Wide-field fundus image from infant ROP screening · acquired on the Phoenix ICON · 1240 x 1240 pixels — 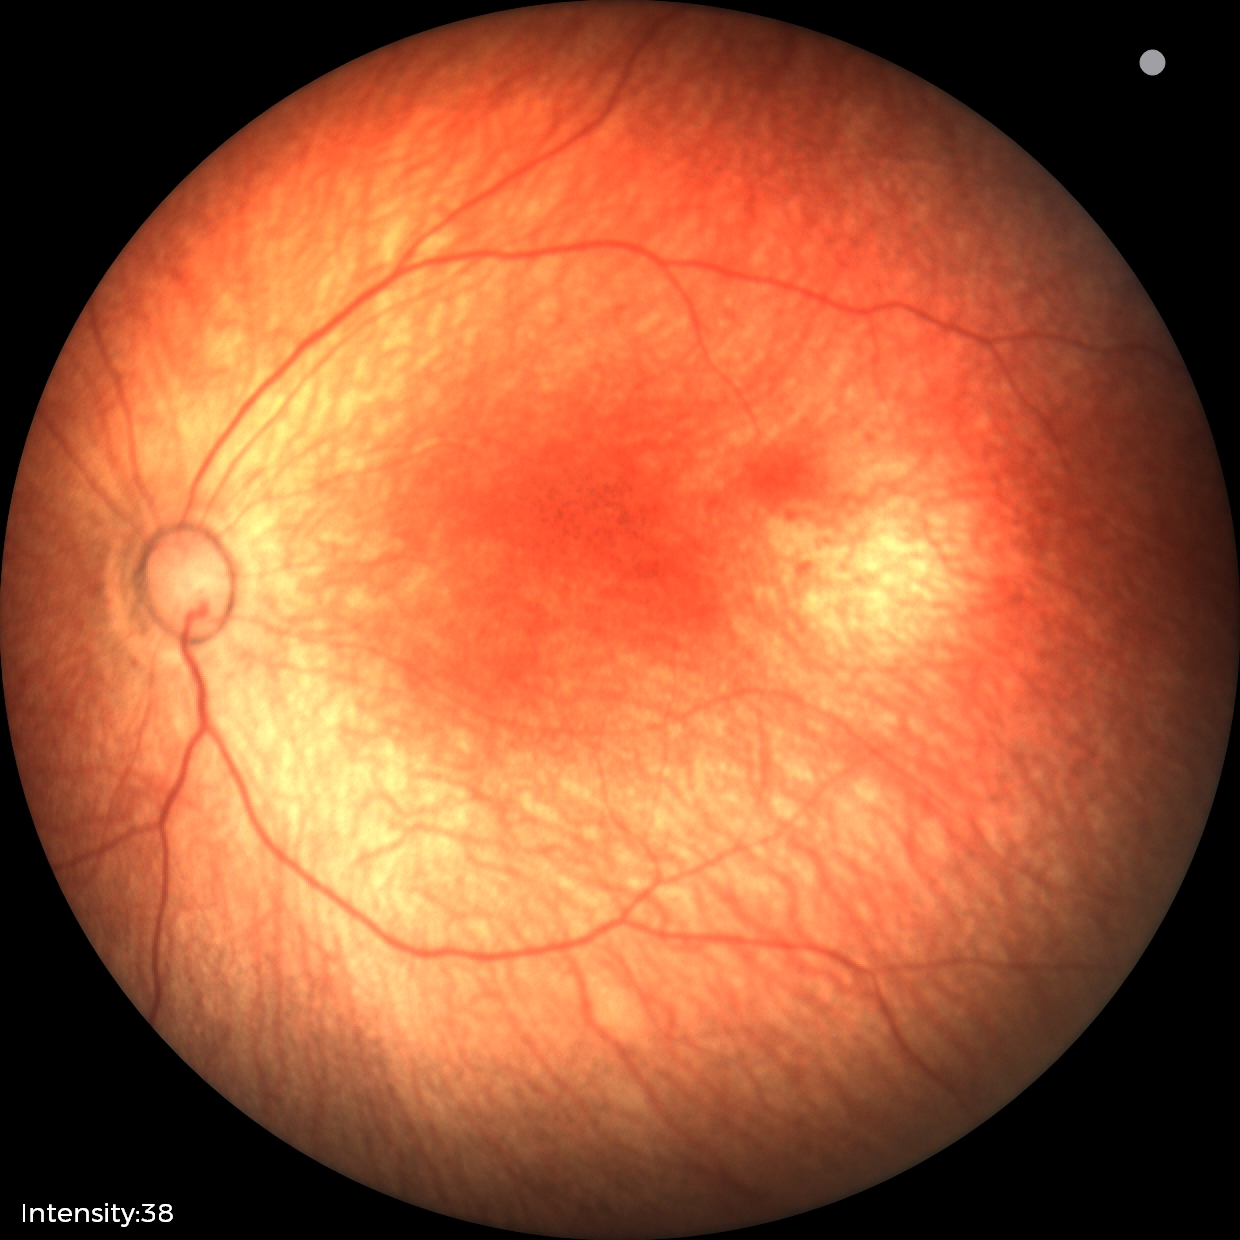 Diagnosis = physiological.